Patient age: 50 years. 2212x1661. Intraocular pressure by non-contact tonometry: 17 mmHg. Central corneal thickness: 535 µm. Sex: F. Non-mydriatic acquisition. Autorefraction: +3.5 -0.75 × 102°
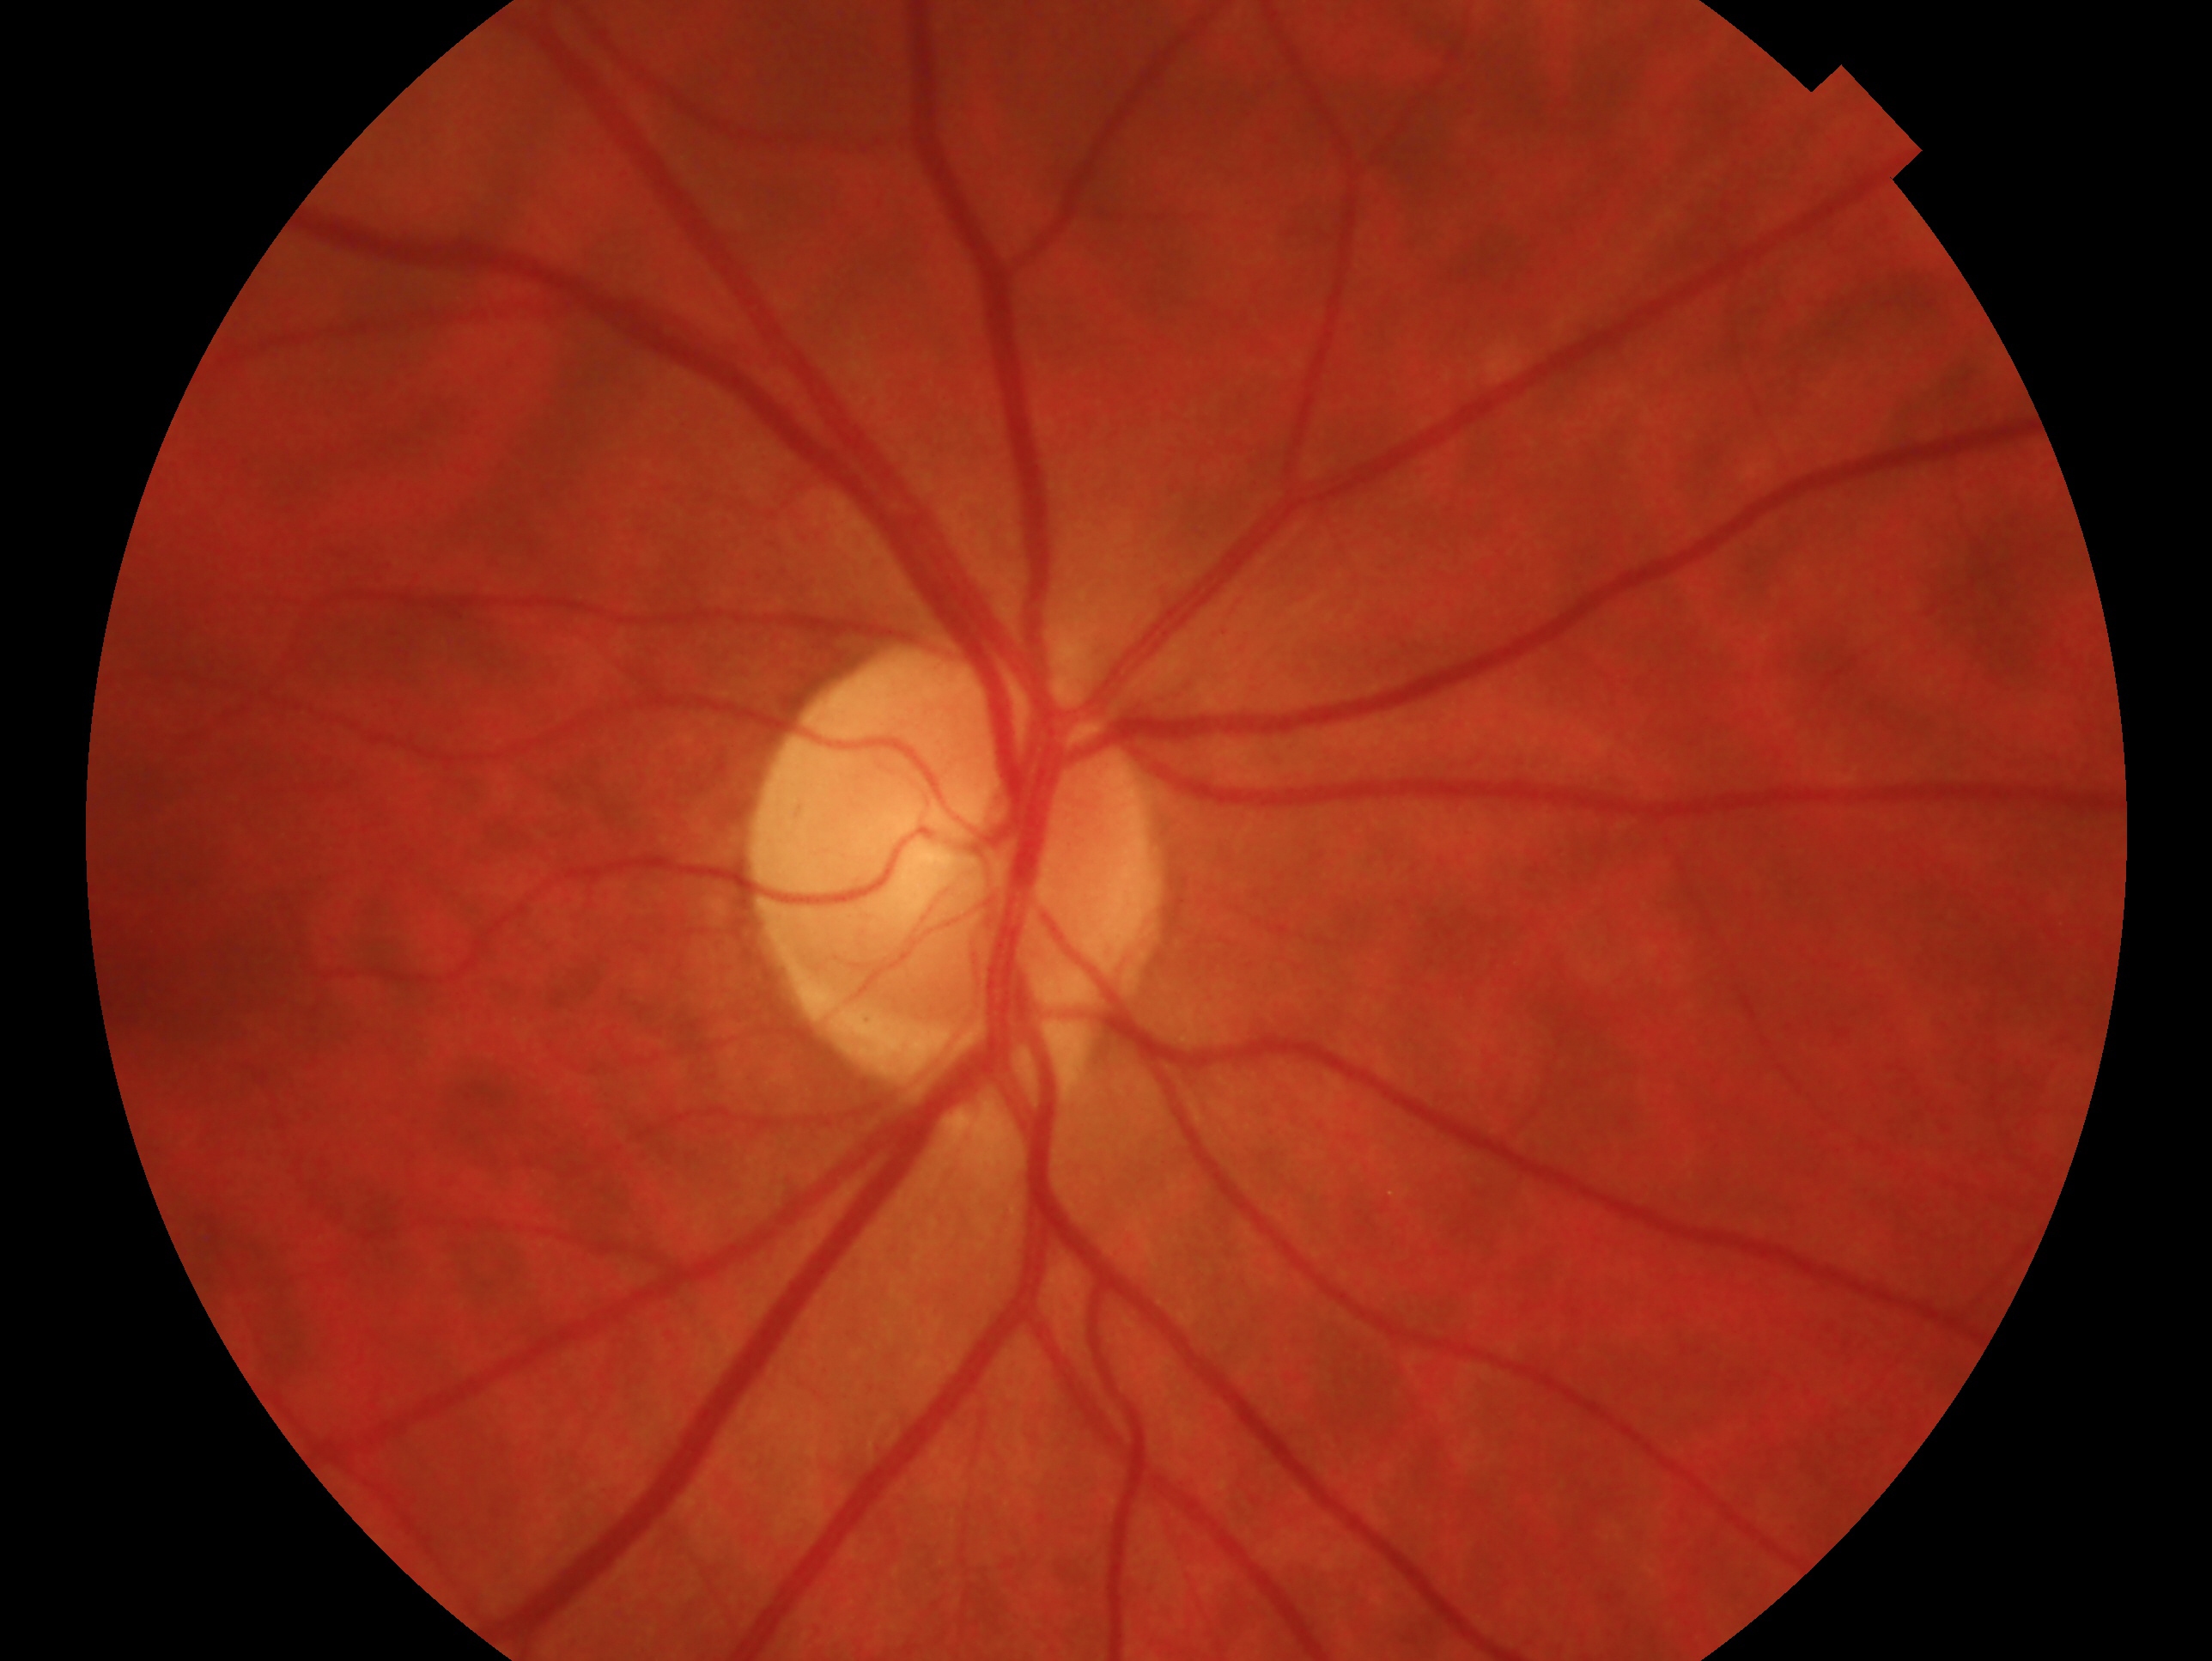
clinical classification: no glaucomatous findings
laterality: right